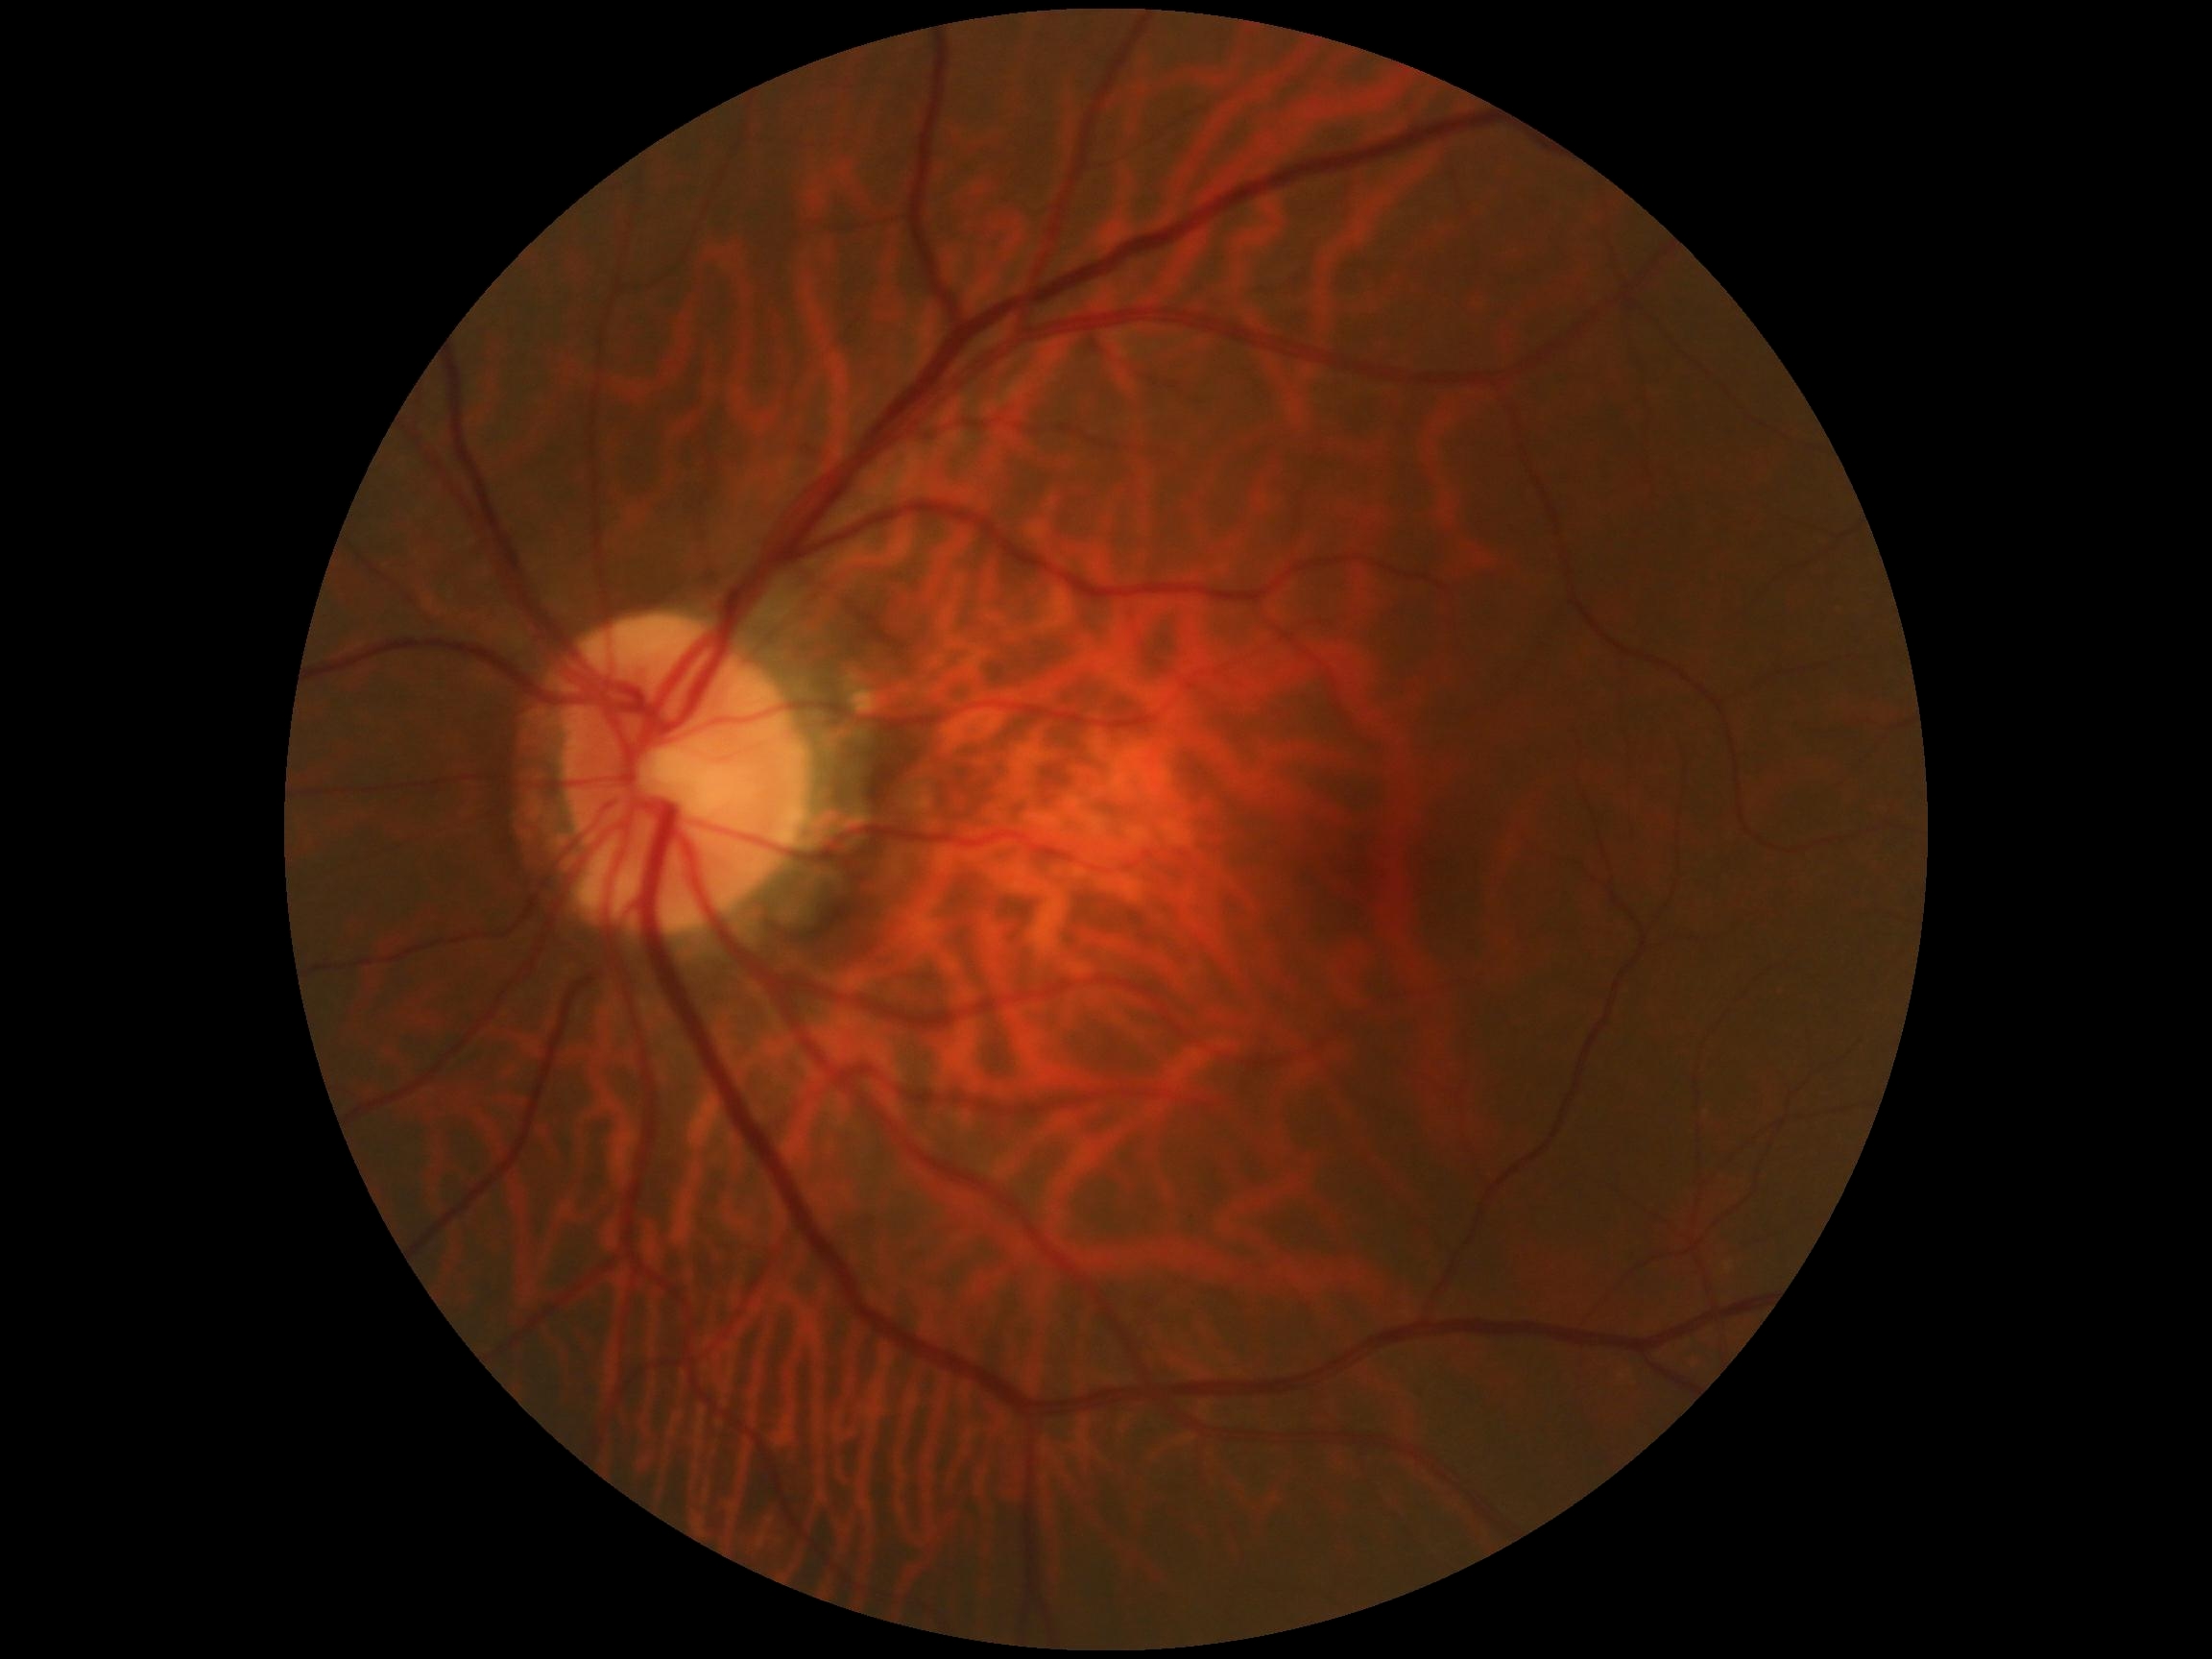

Diabetic retinopathy severity: 0/4.